Graded on the modified Davis scale:
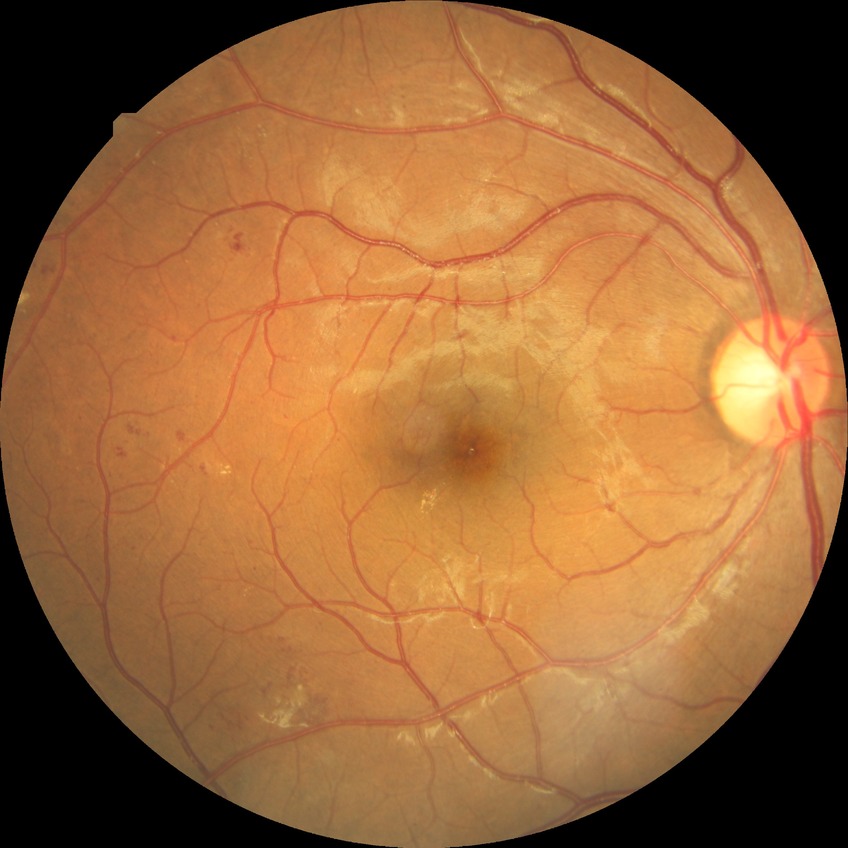
Retinopathy grade: simple diabetic retinopathy.